CFP, 2352 by 1568 pixels, 45° FOV: 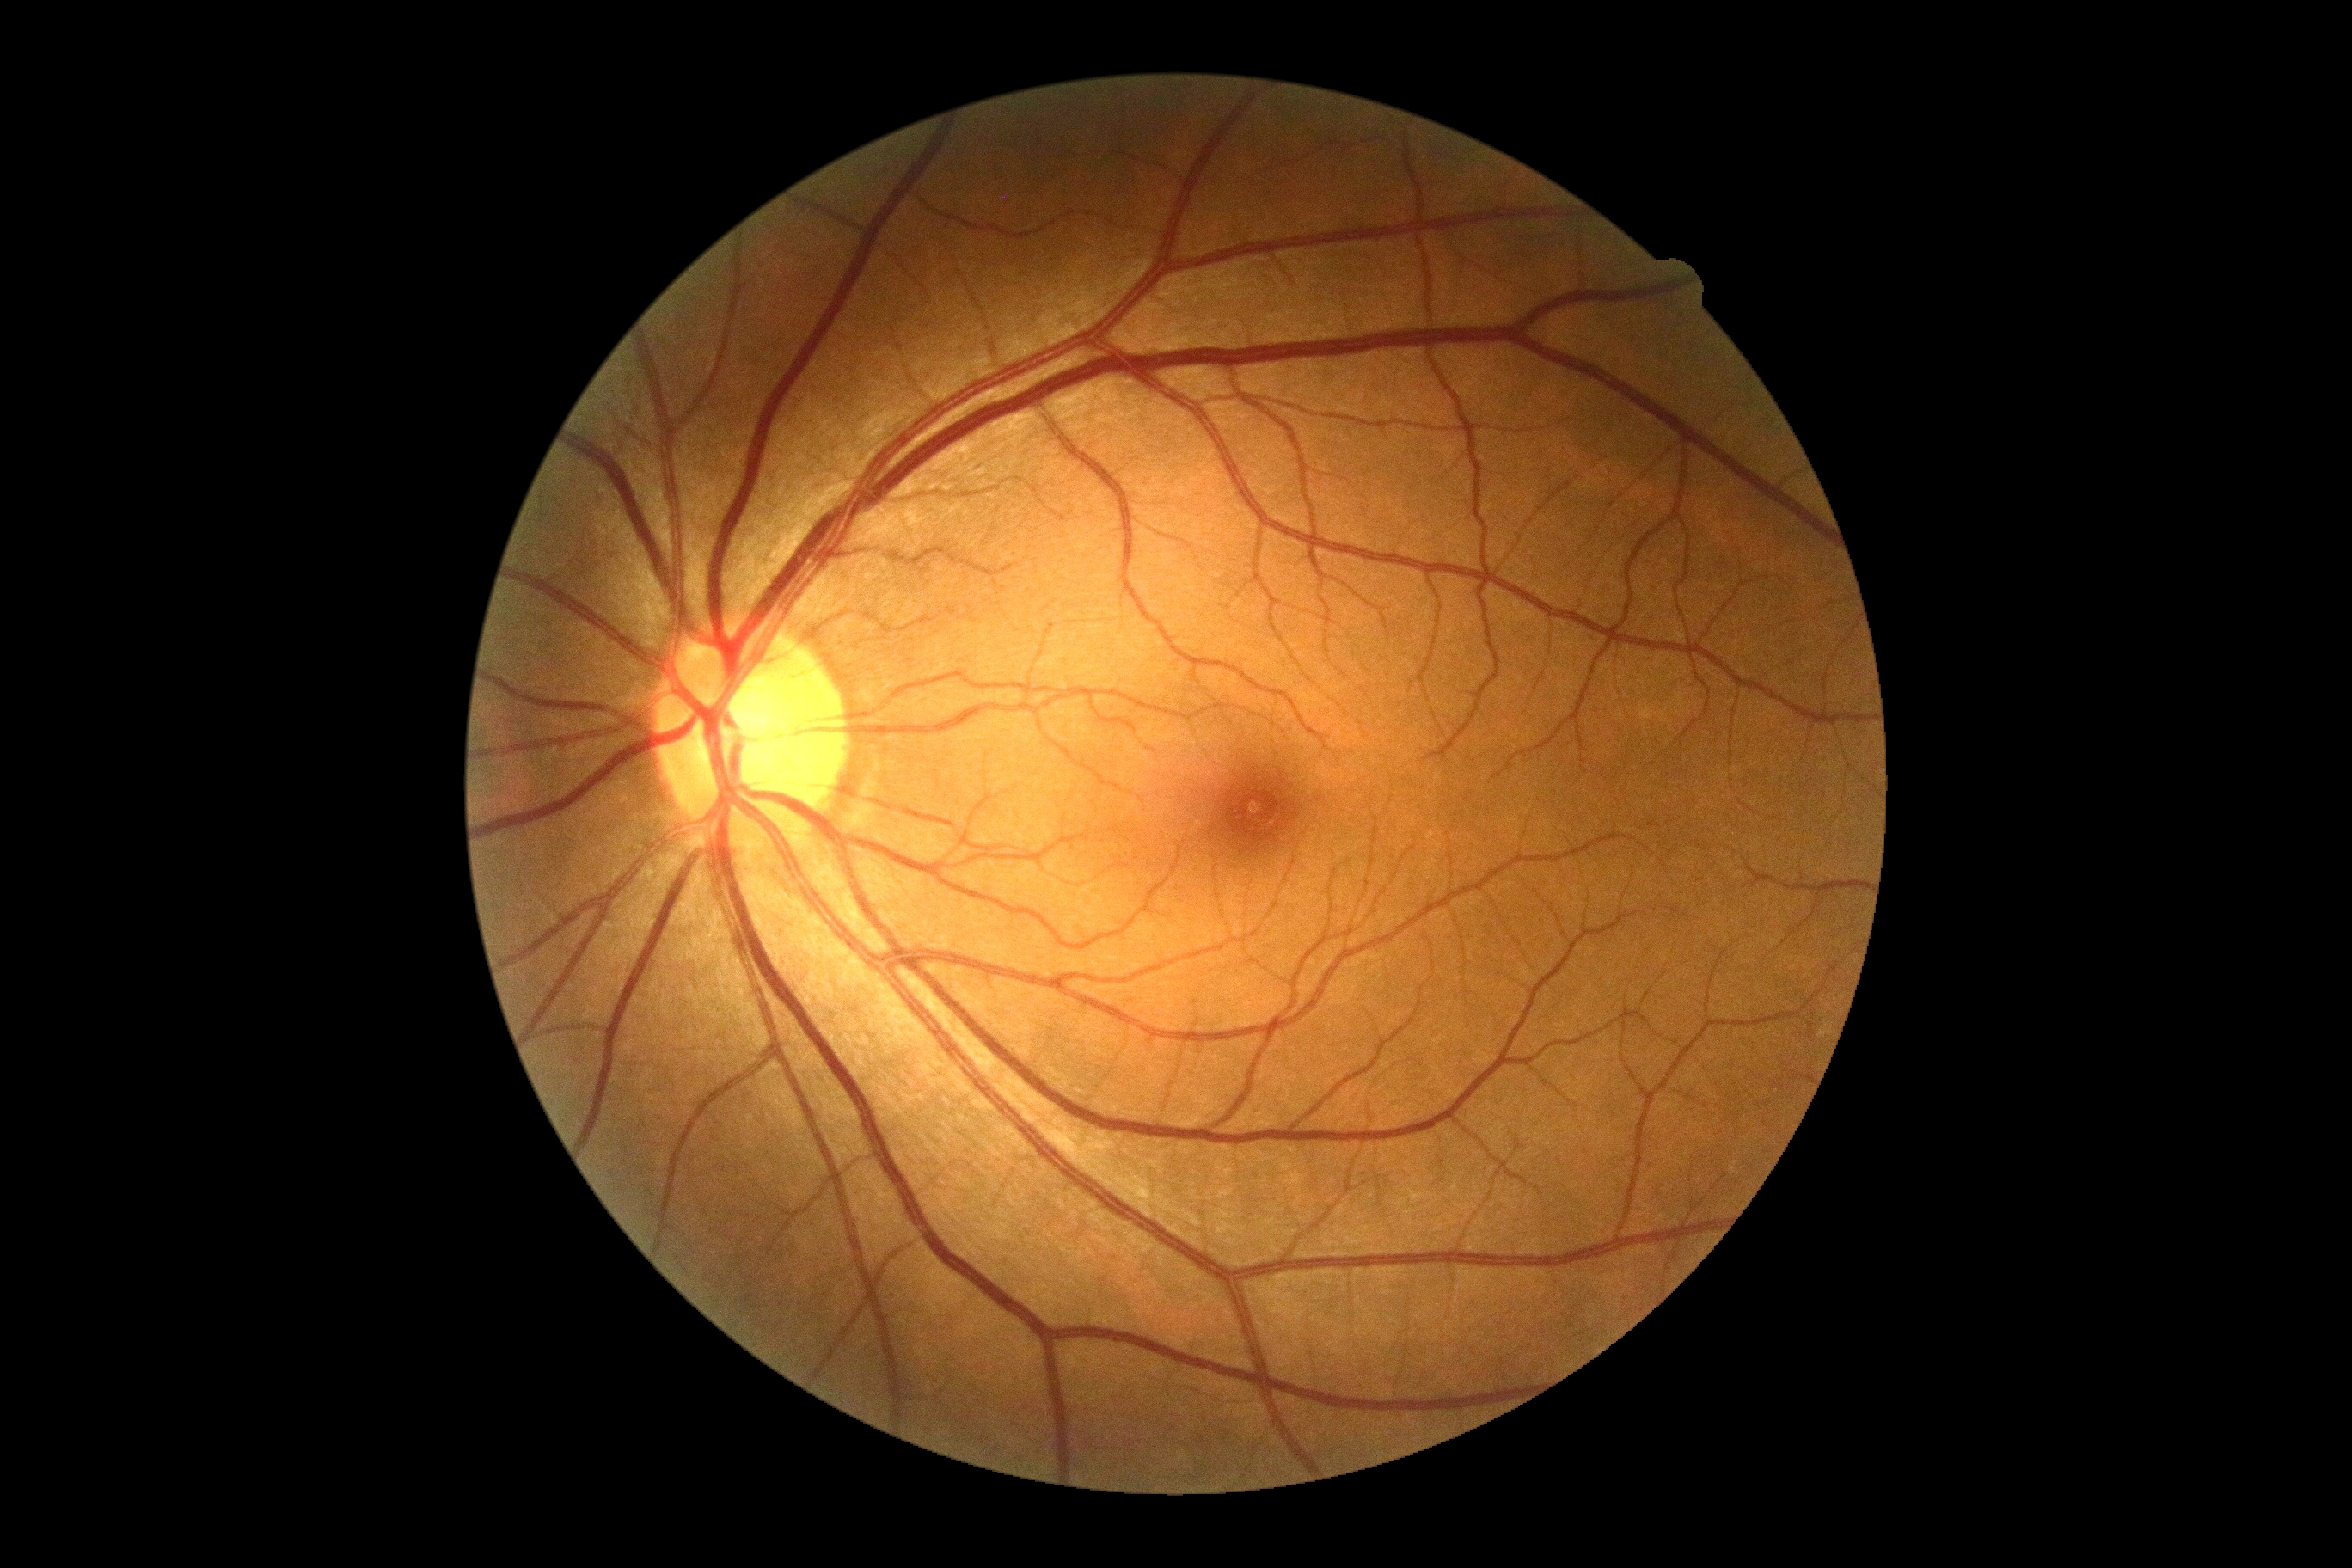
Diabetic retinopathy severity: 0/4.